Field includes the optic disc and macula. Acquired with a Topcon TRC-50DX. Mydriatic (tropicamide and phenylephrine). Retinal fundus photograph:
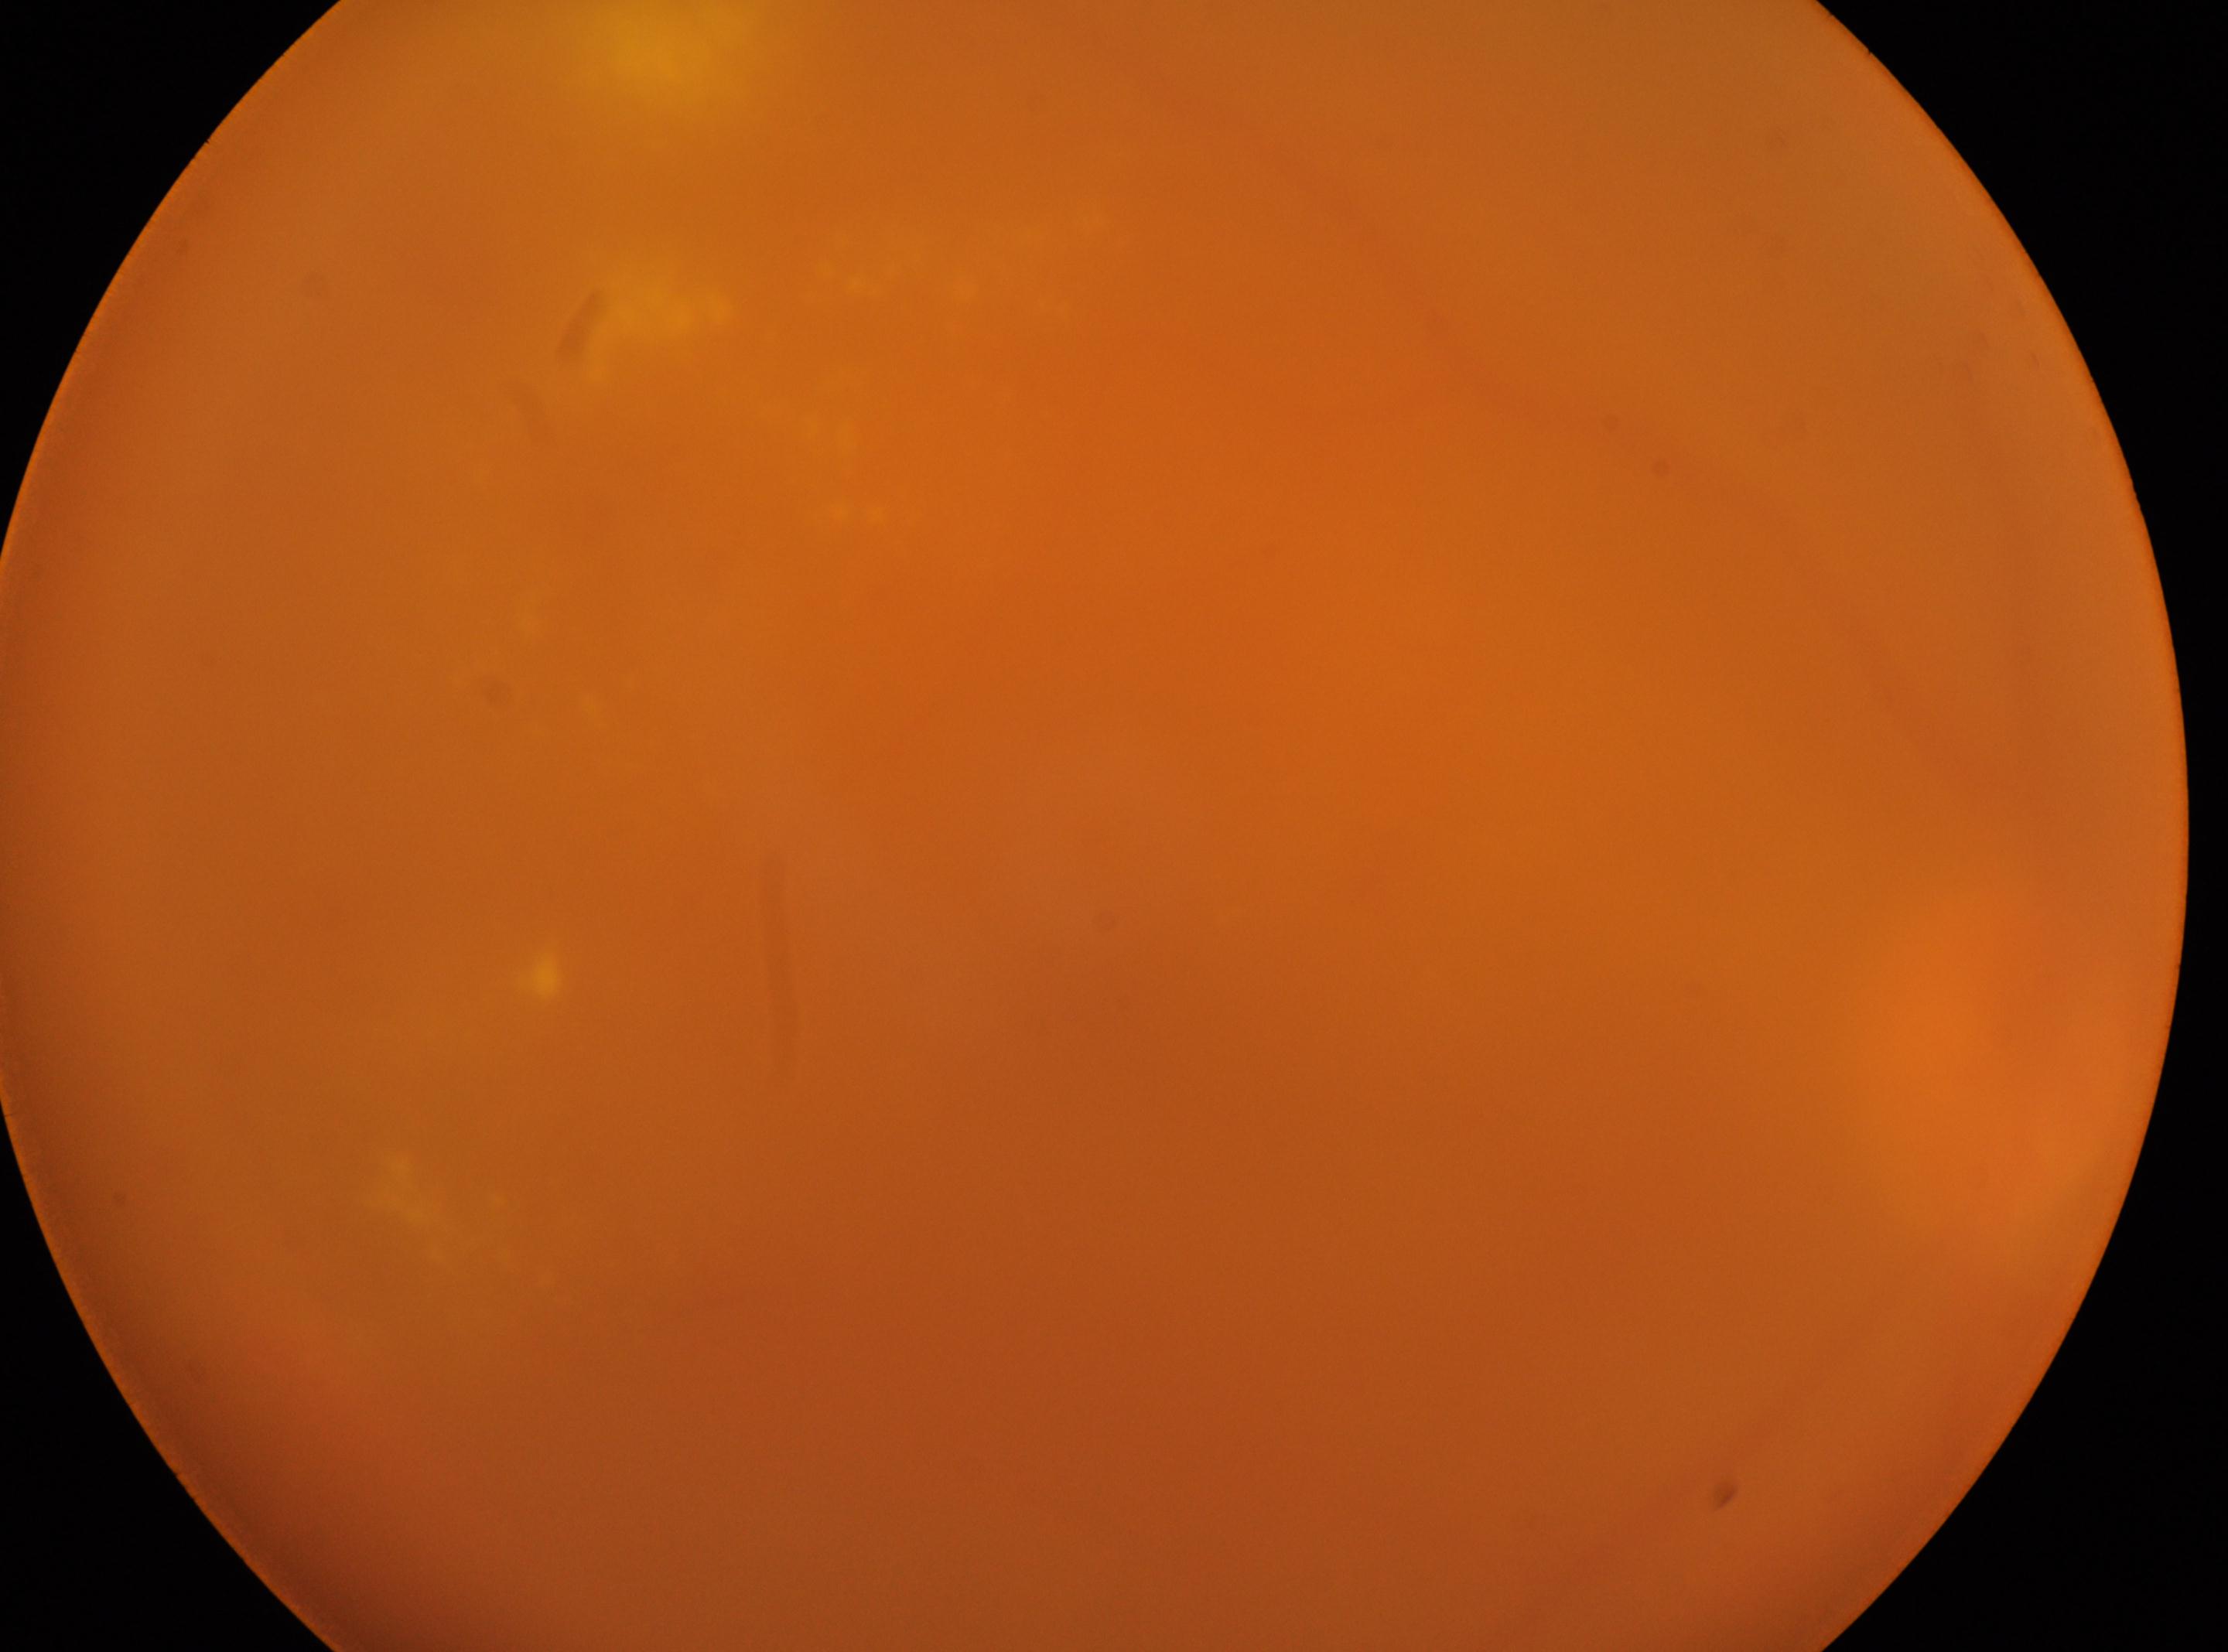

– laterality: the right eye
– DR stage: 4/4
– foveal center: (1106, 1047)
– optic disk: (1985, 1058)